848x848; diabetic retinopathy graded by the modified Davis classification; camera: NIDEK AFC-230 — 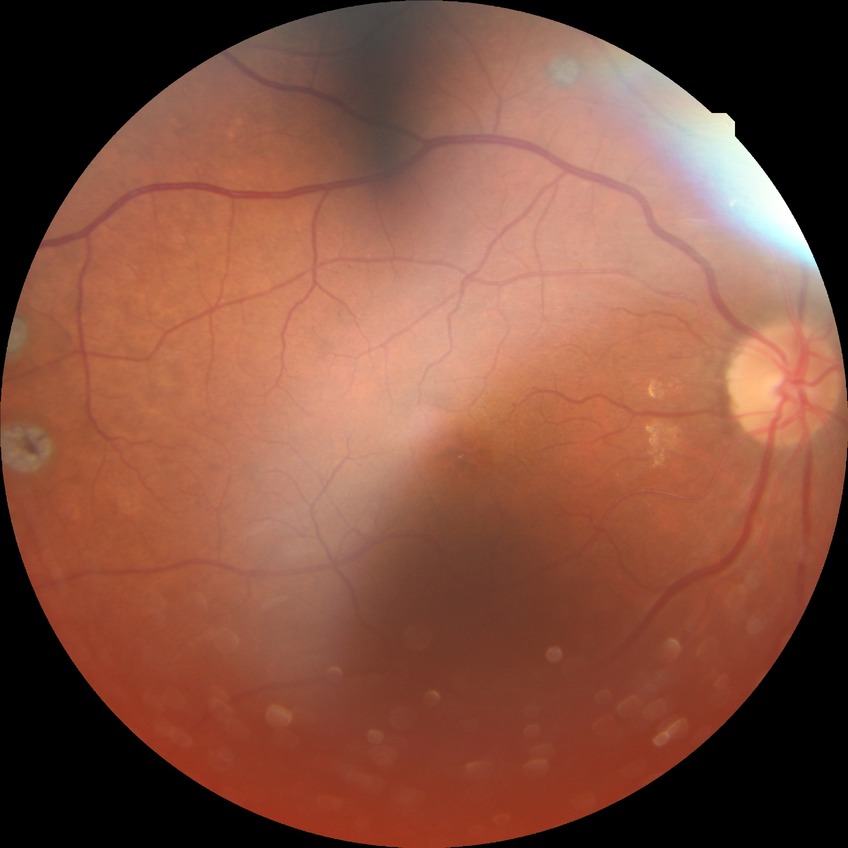

Davis stage: PDR.